Portable fundus camera image; 2212 x 1659 pixels — 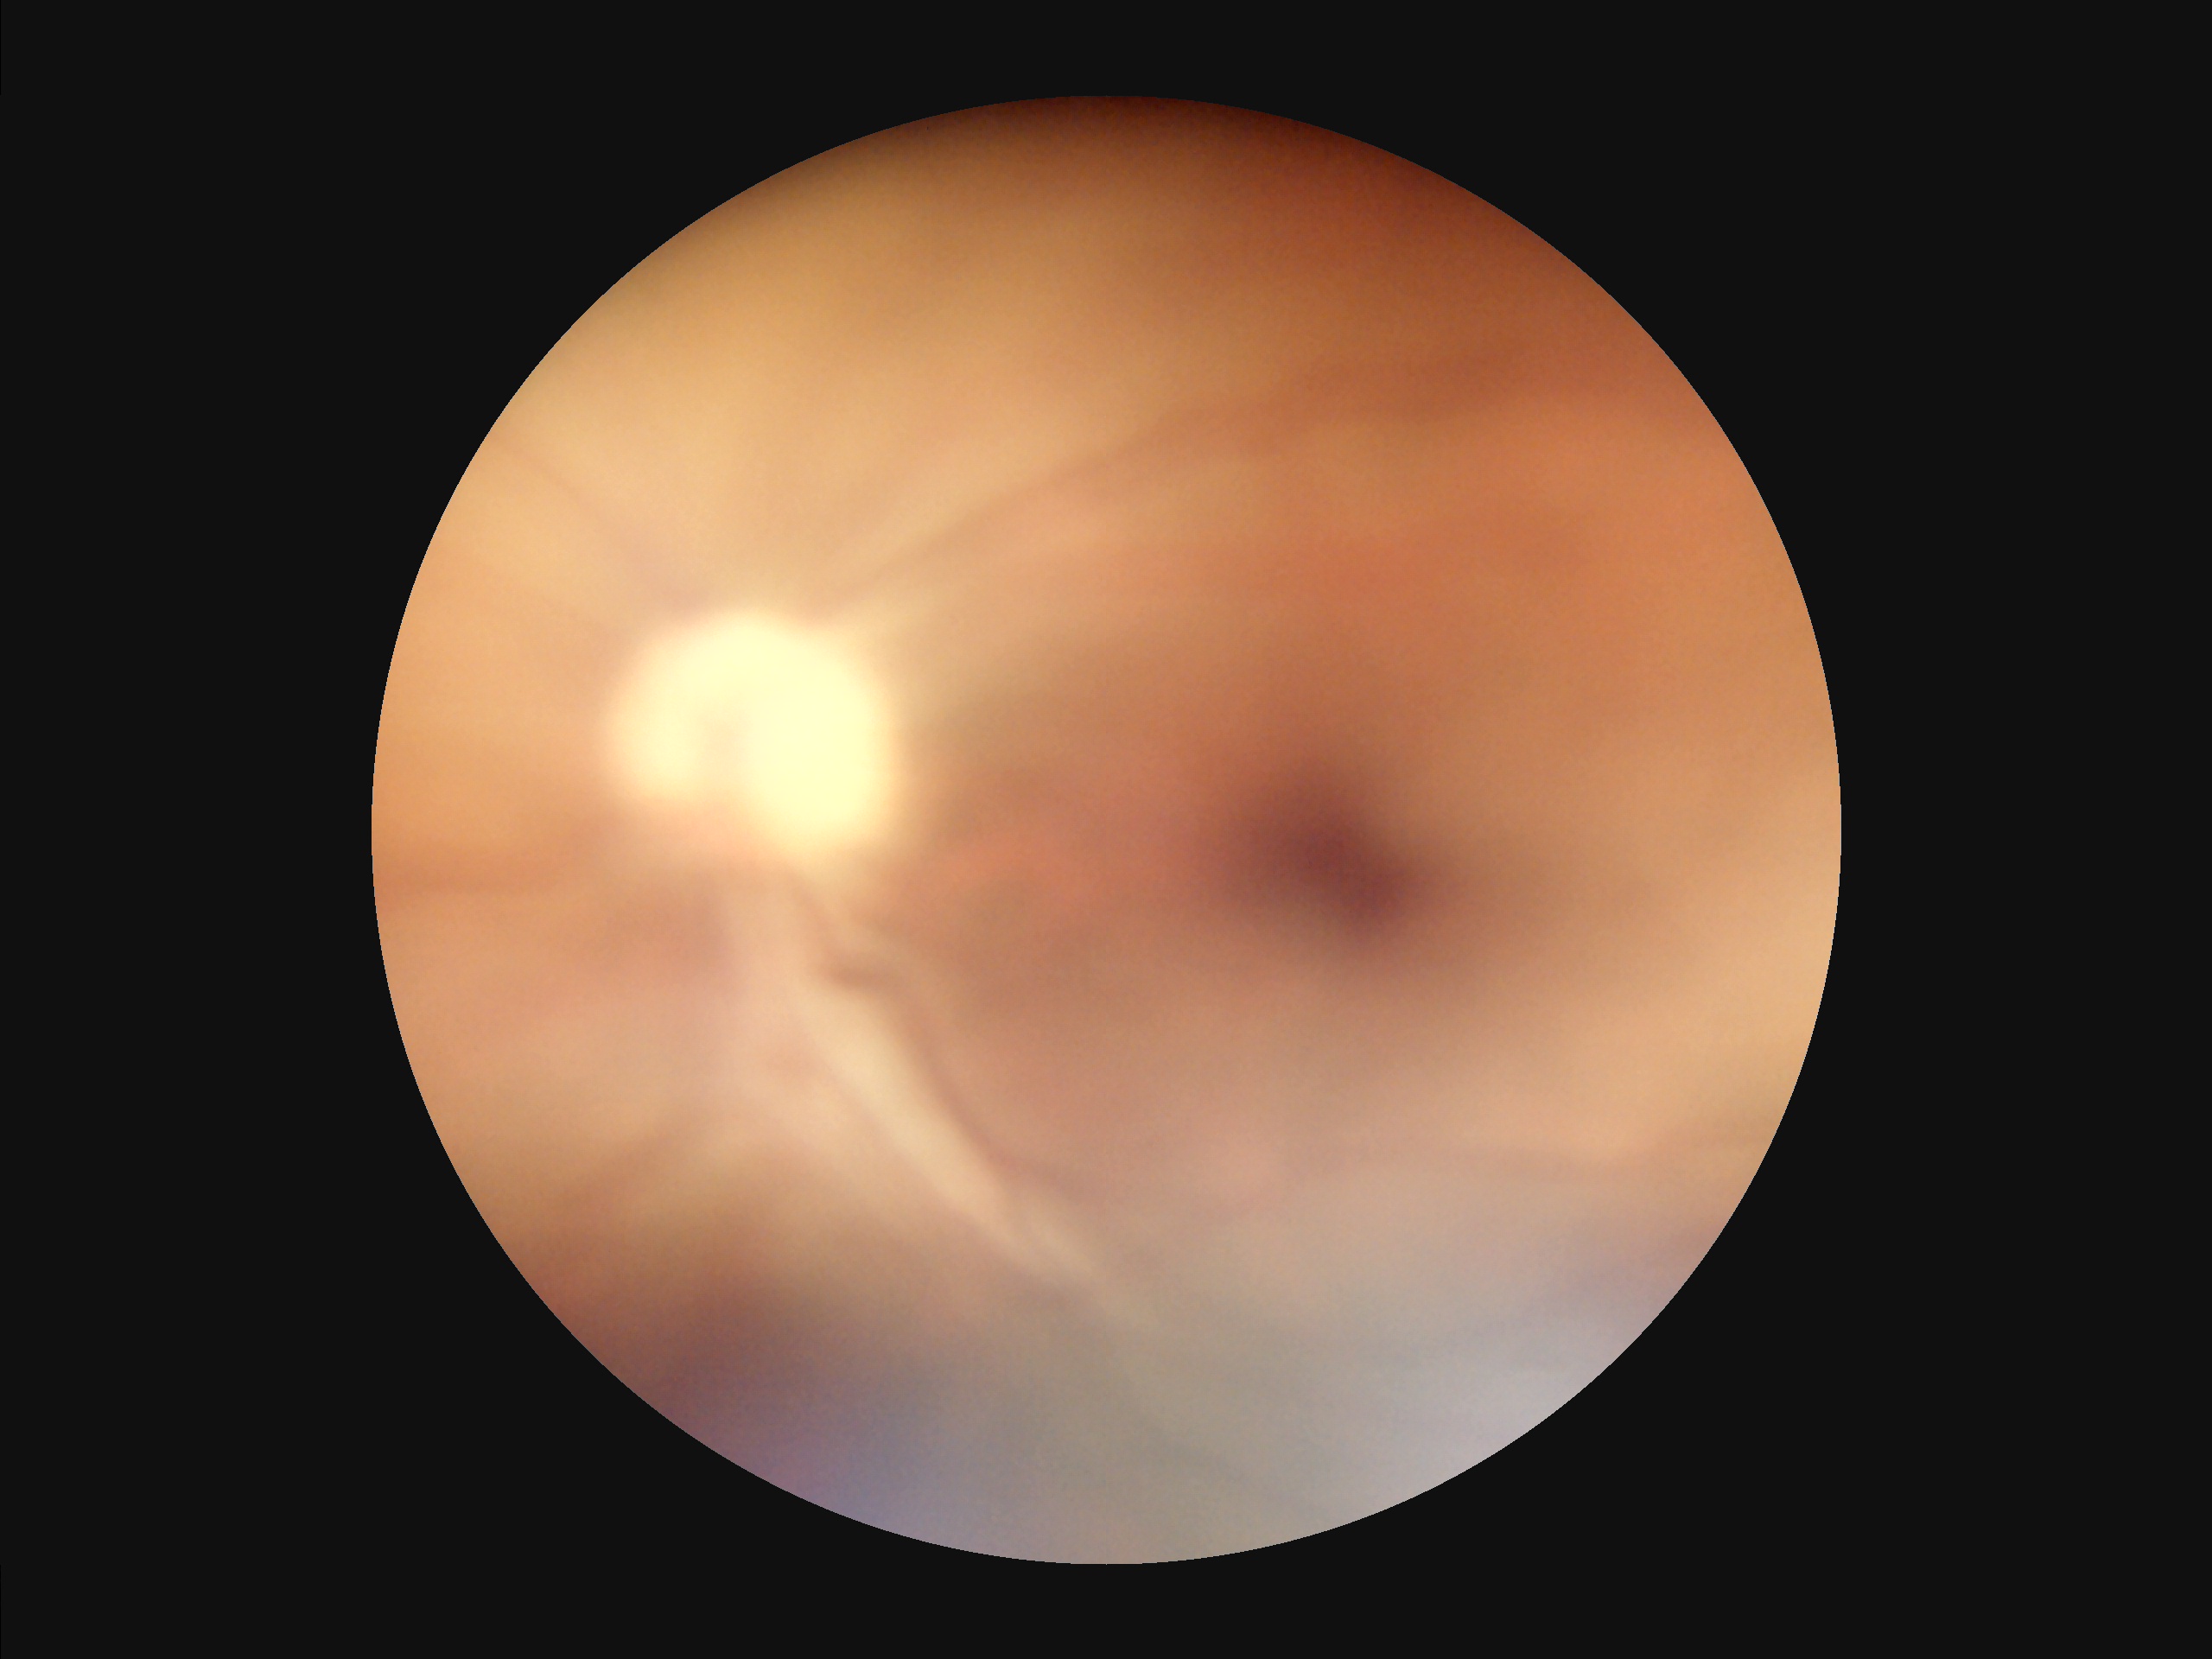
Illumination is uneven.
Overall image quality is poor.
Noticeable blur in the optic disc, vessels, or background.
Vessels and details are hard to distinguish.